FOV: 45 degrees, 2346x1568, color fundus photograph — 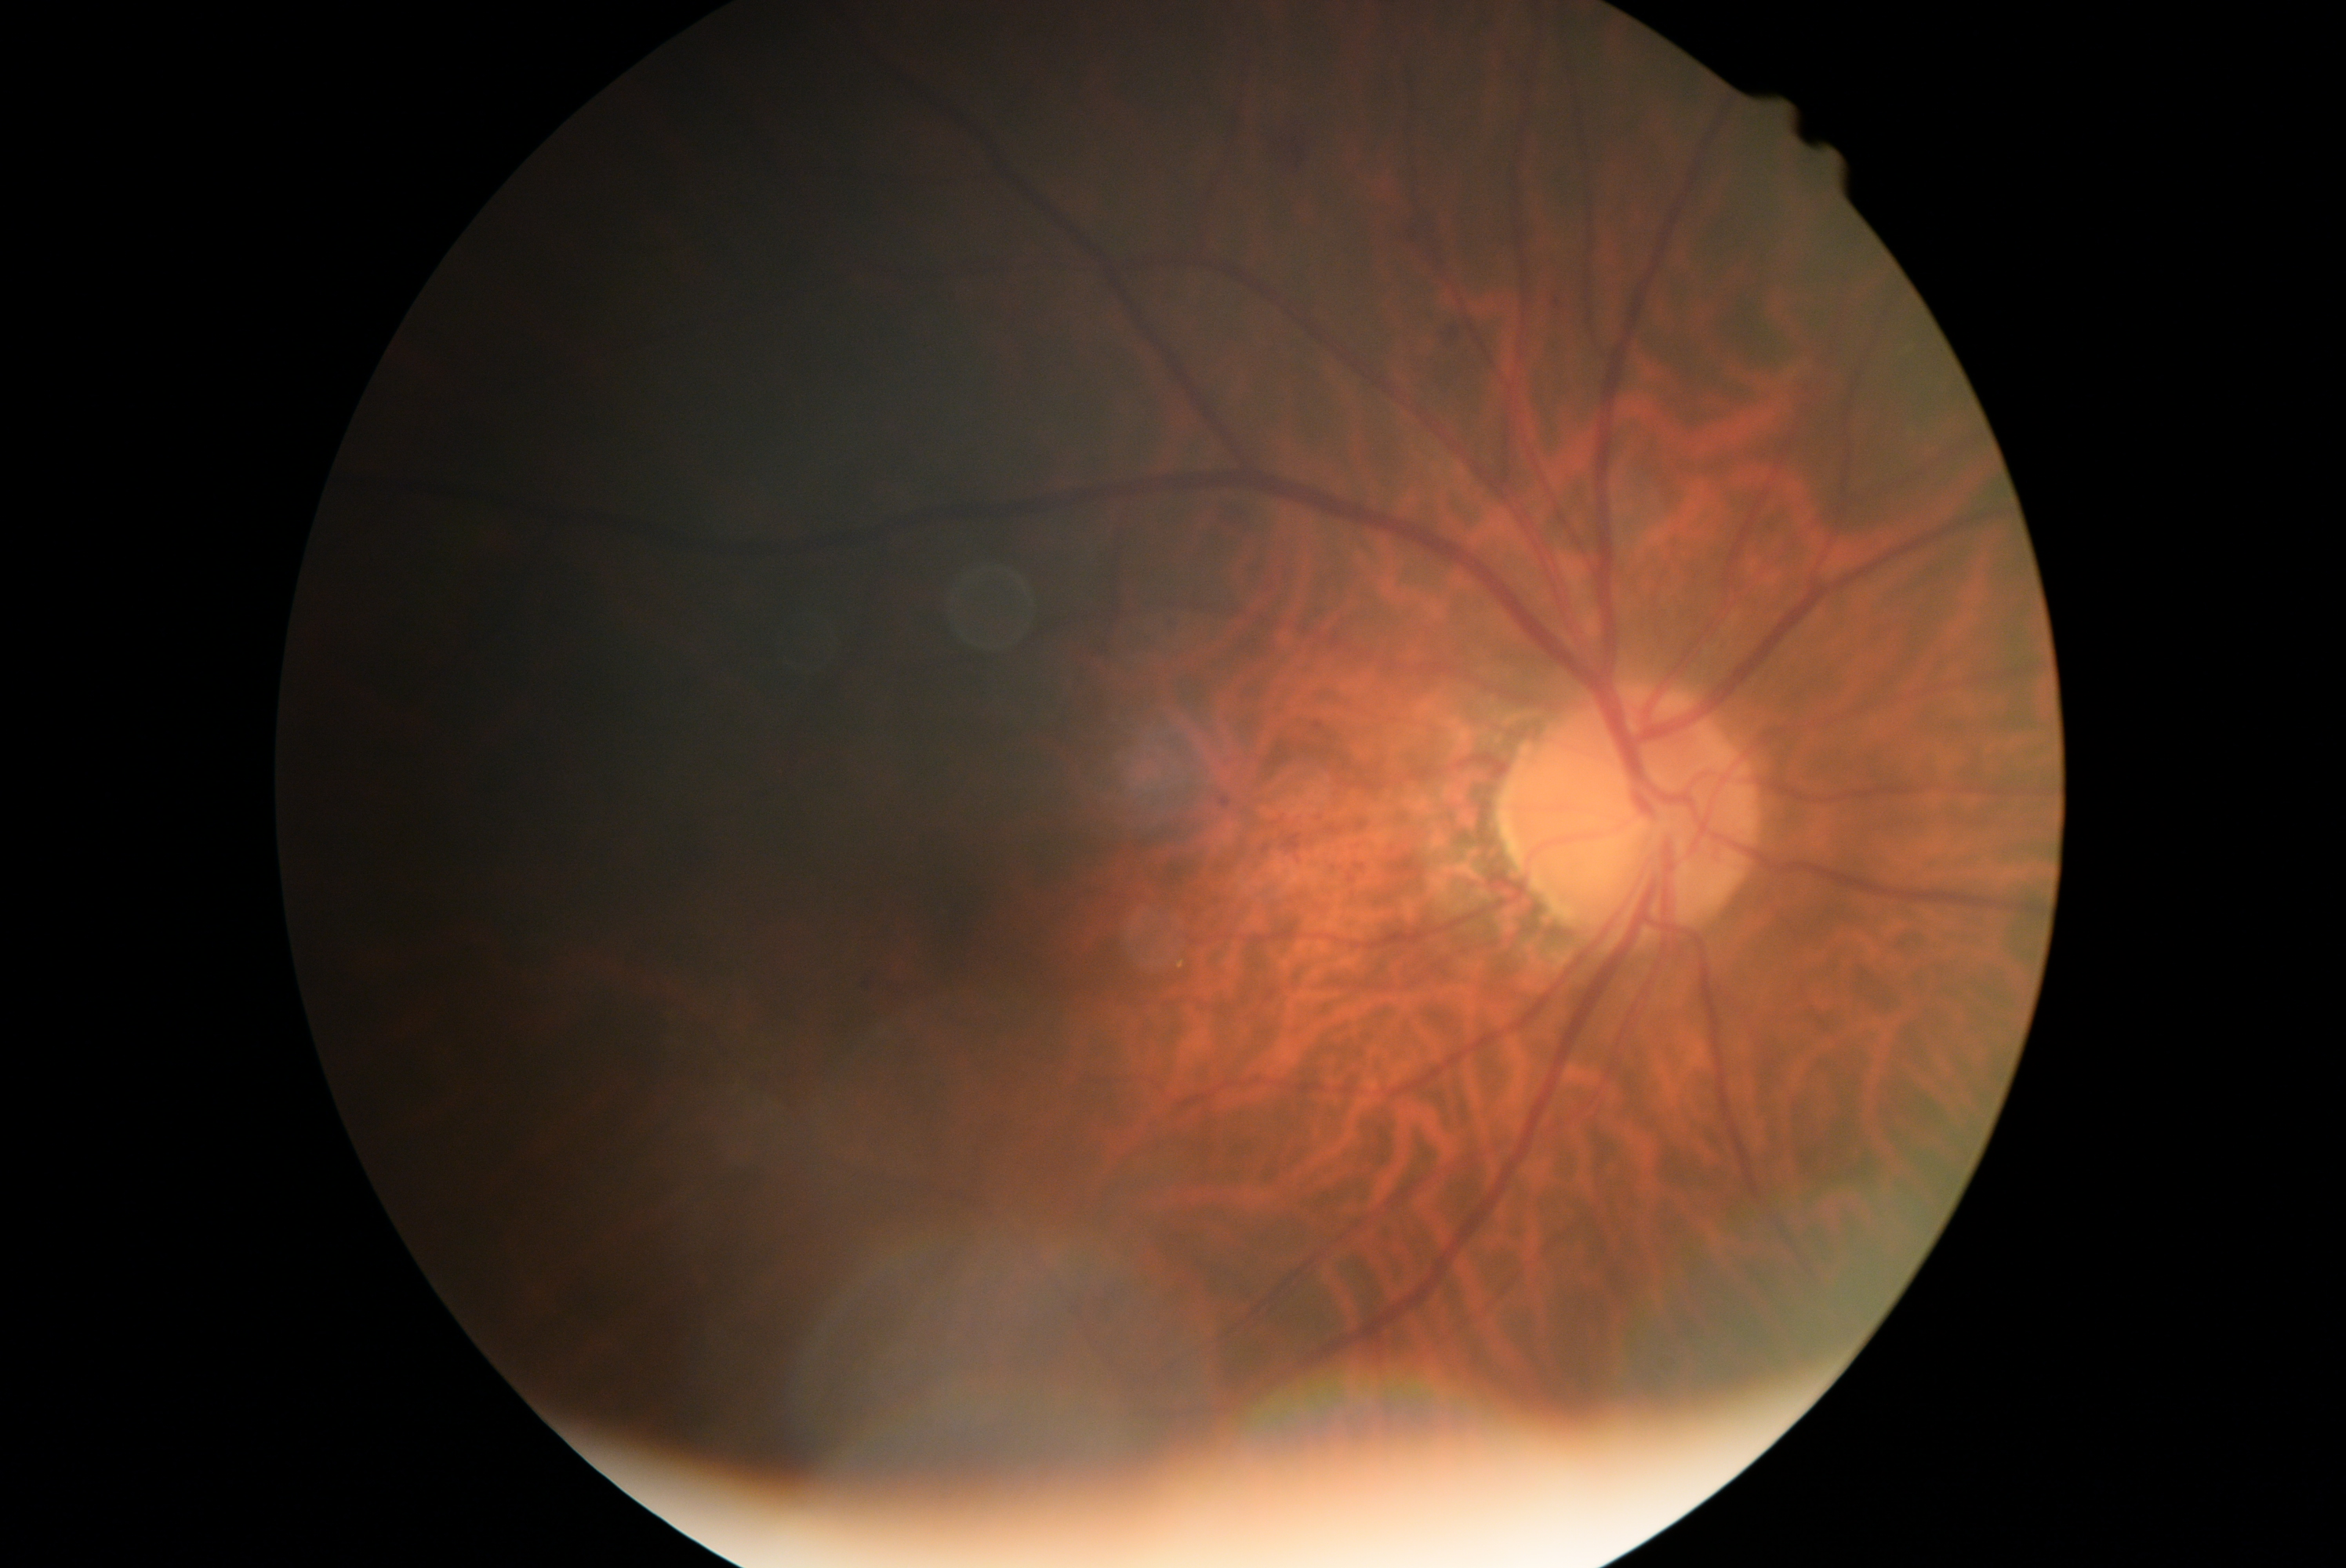

DR grade is moderate non-proliferative diabetic retinopathy (2).